Fundus photo
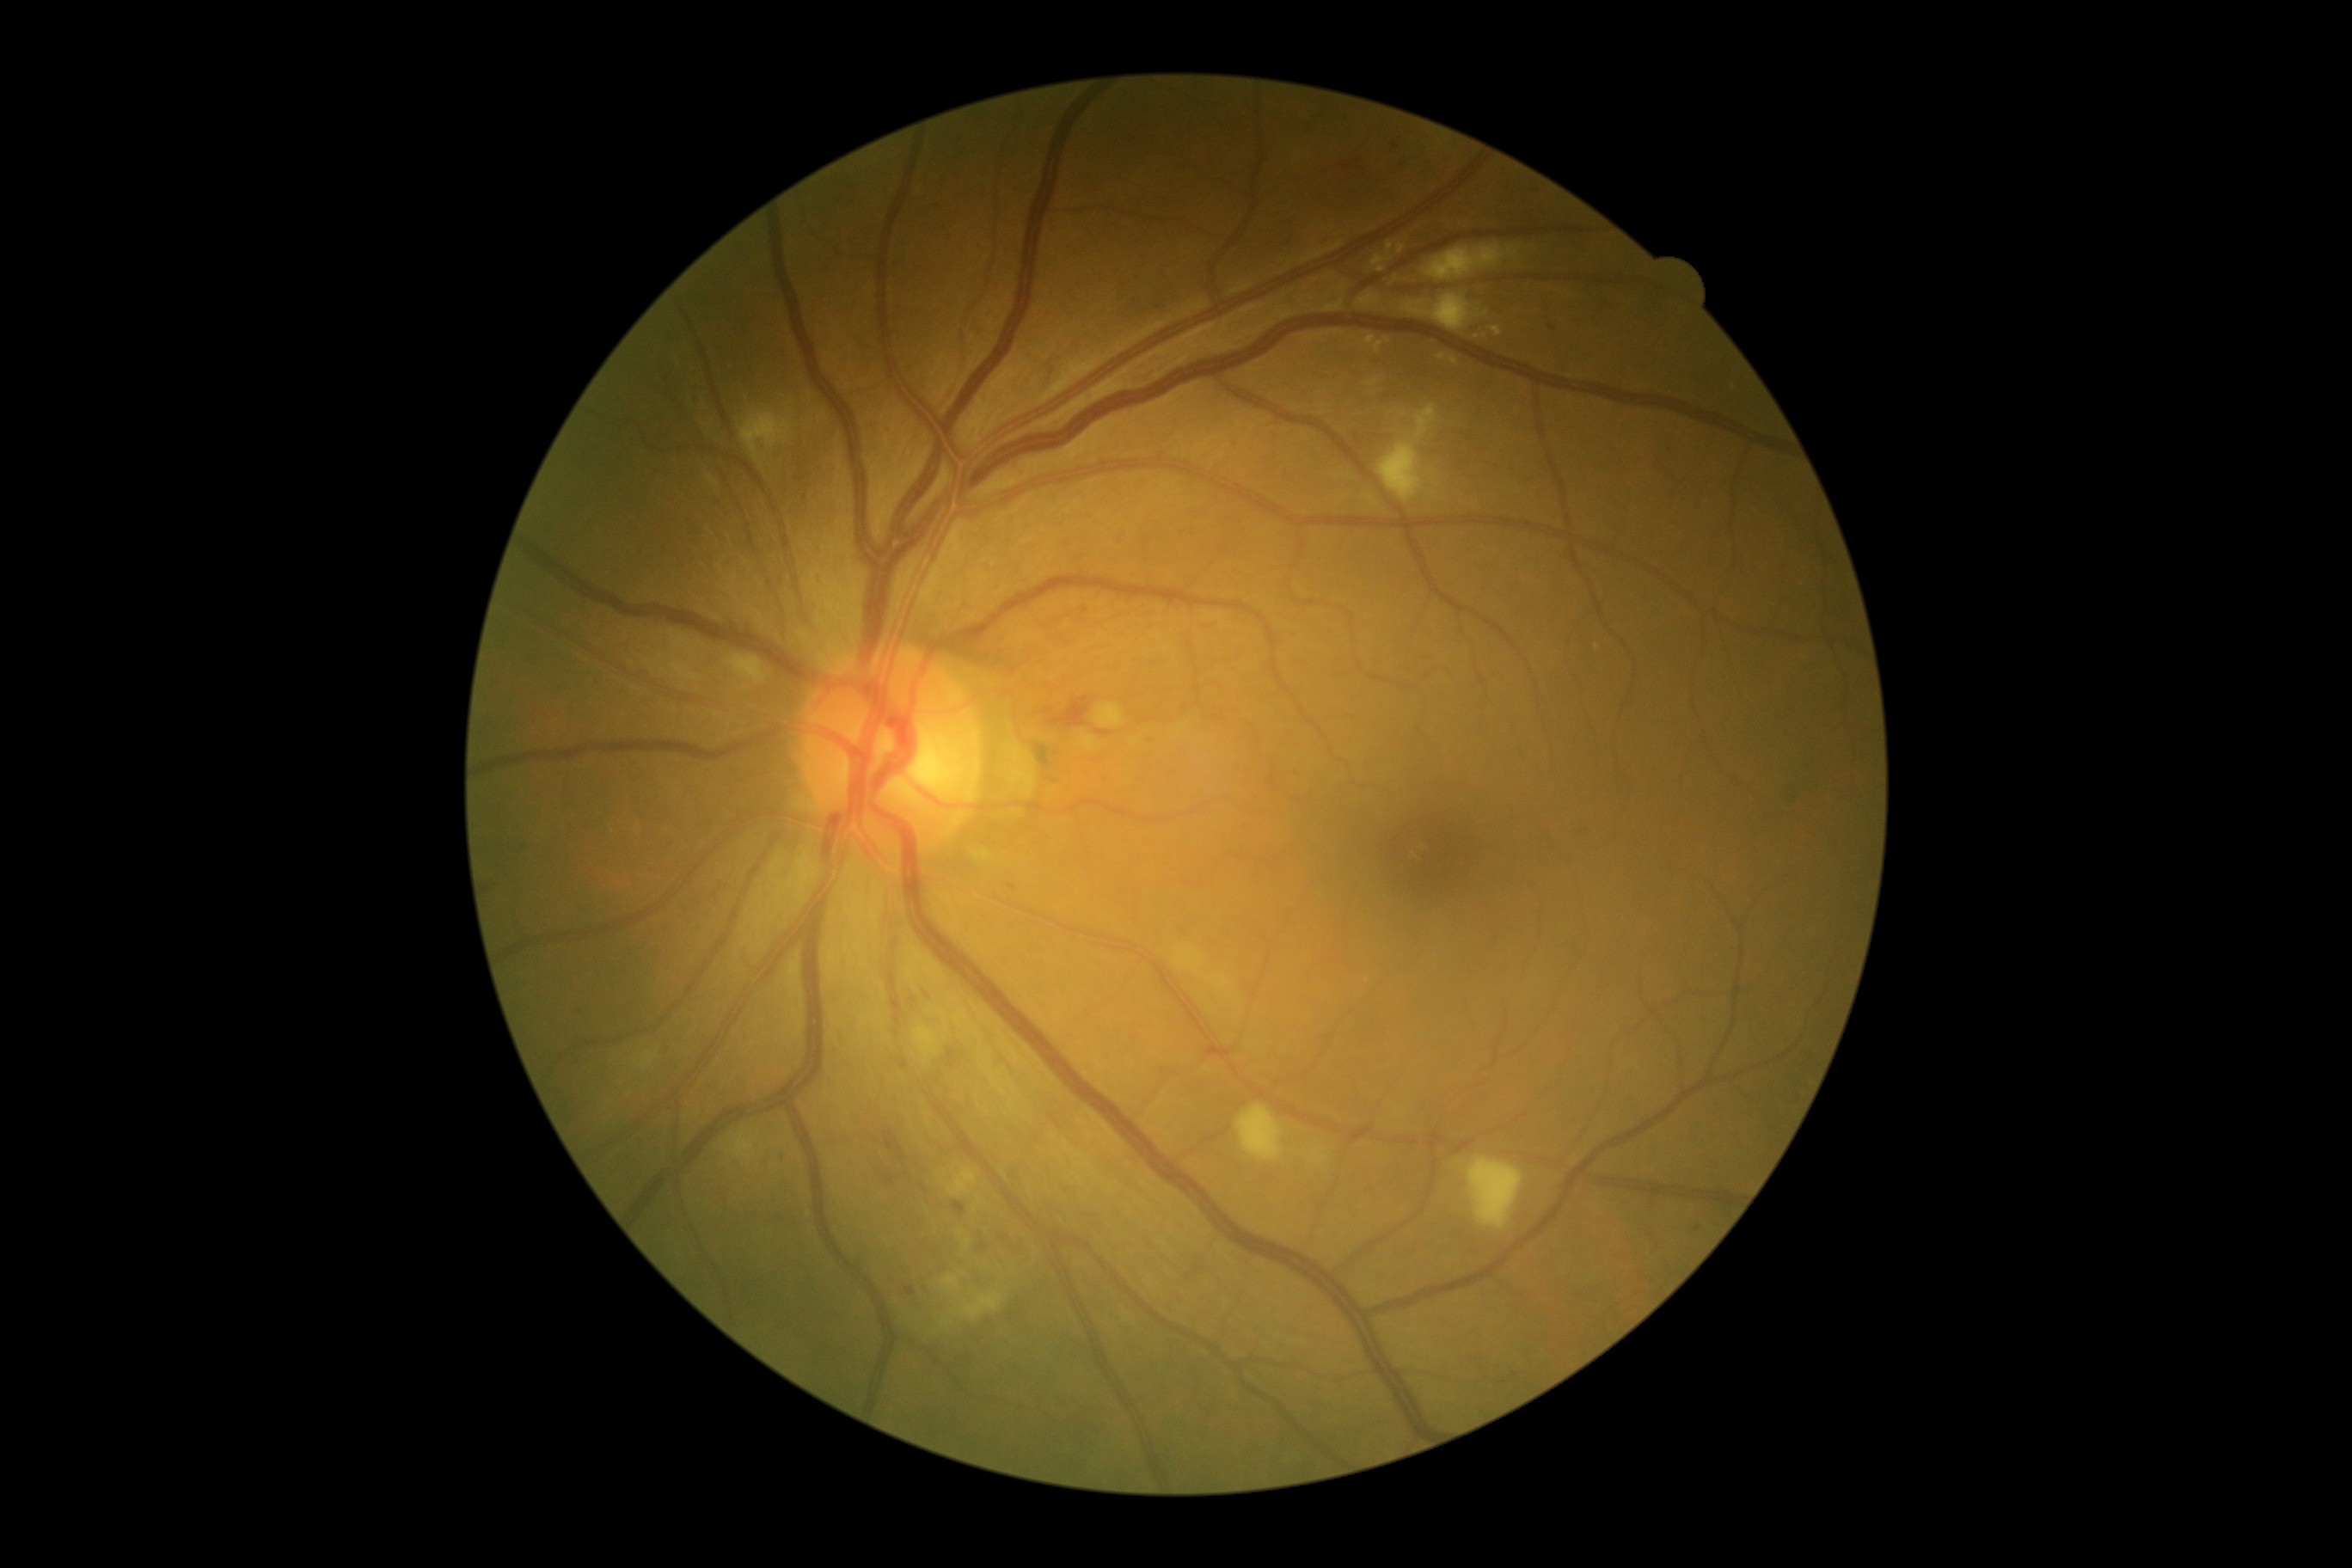
diabetic retinopathy (DR)@grade 2 (moderate NPDR) — more than just microaneurysms but less than severe NPDR.